45° FOV
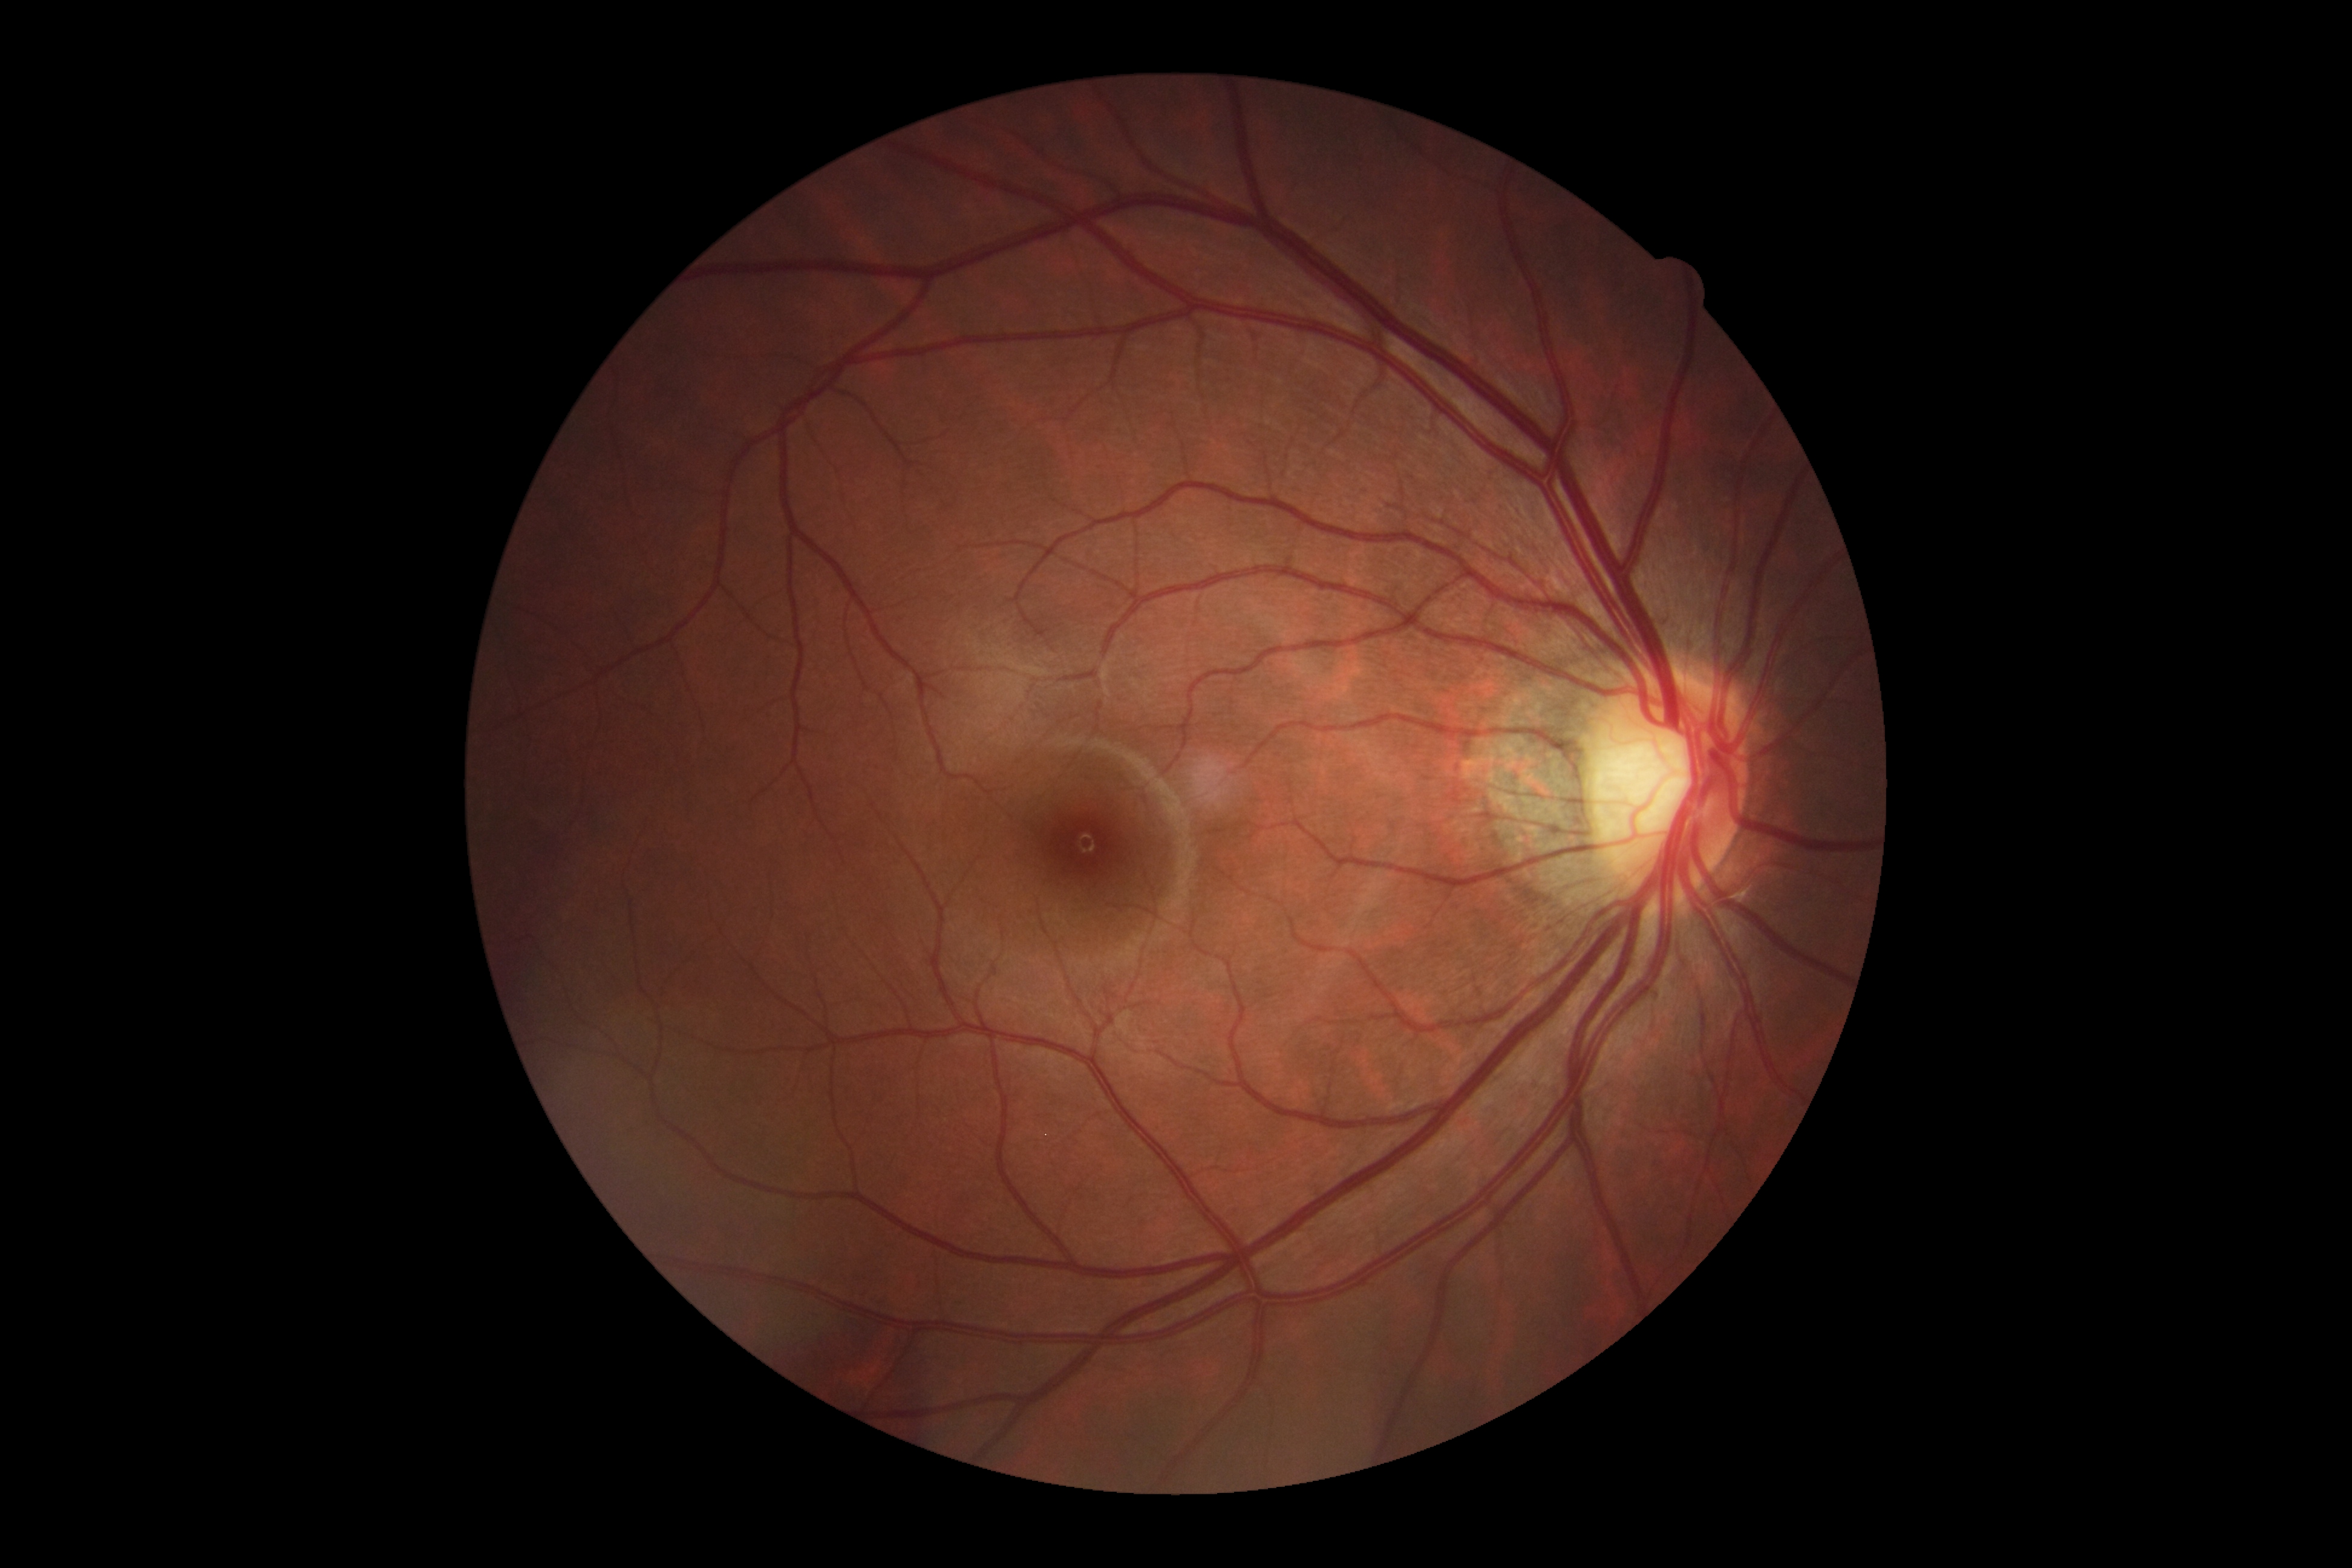

retinopathy grade: 0/4
DR impression: no signs of DR